Posterior pole photograph, 848 by 848 pixels, no pharmacologic dilation
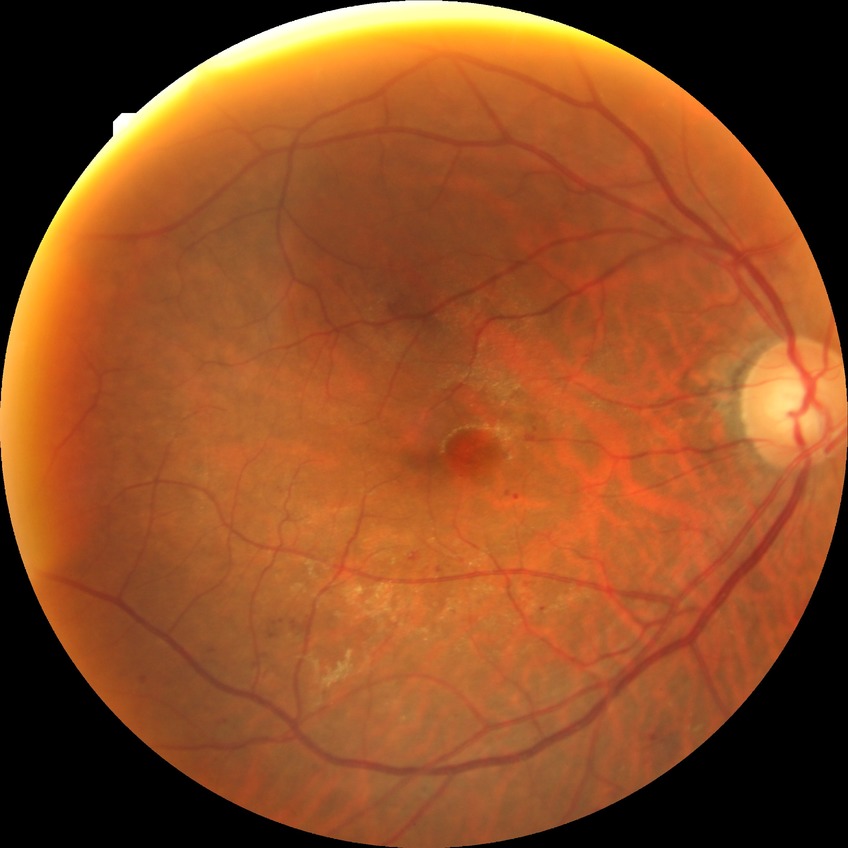
Diabetic retinopathy (DR): simple diabetic retinopathy (SDR).